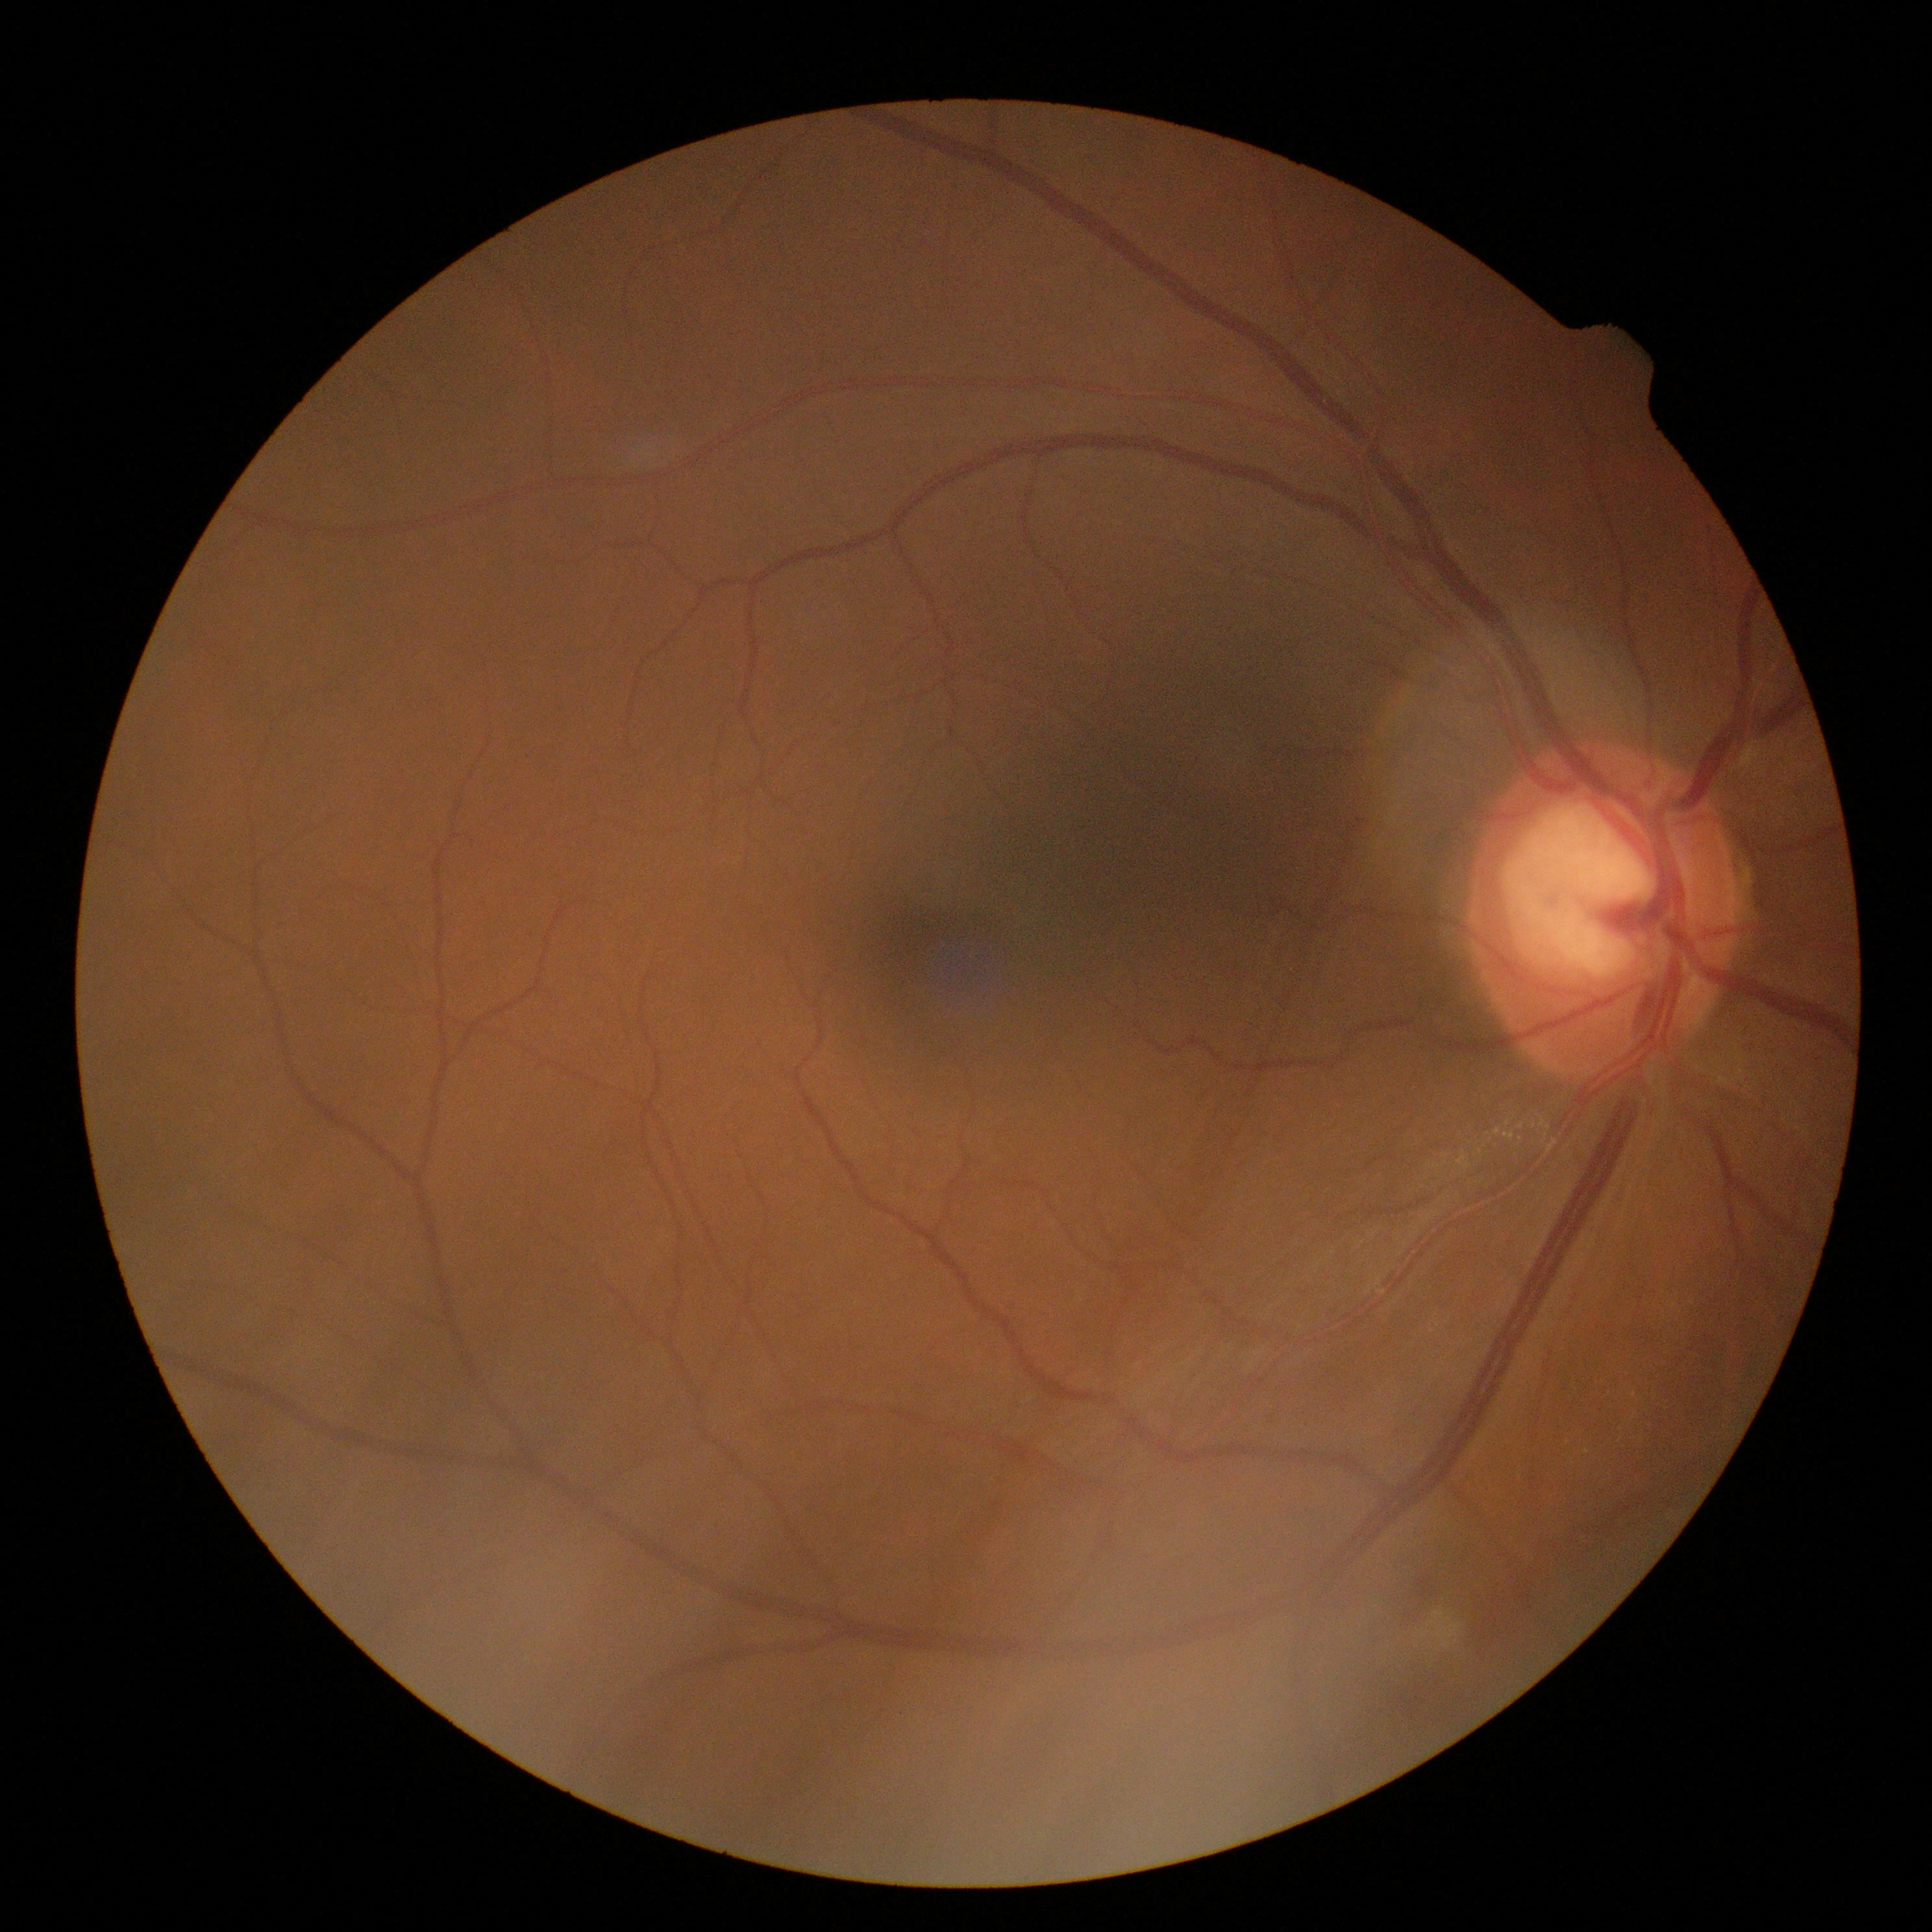
{"dr_grade": "2"}